Infant wide-field fundus photograph.
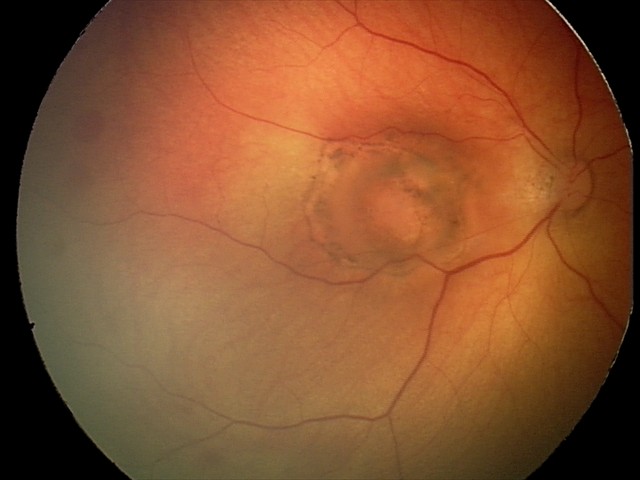
Q: What is the screening diagnosis?
A: toxoplasmosis chorioretinitis